Portable fundus camera image: 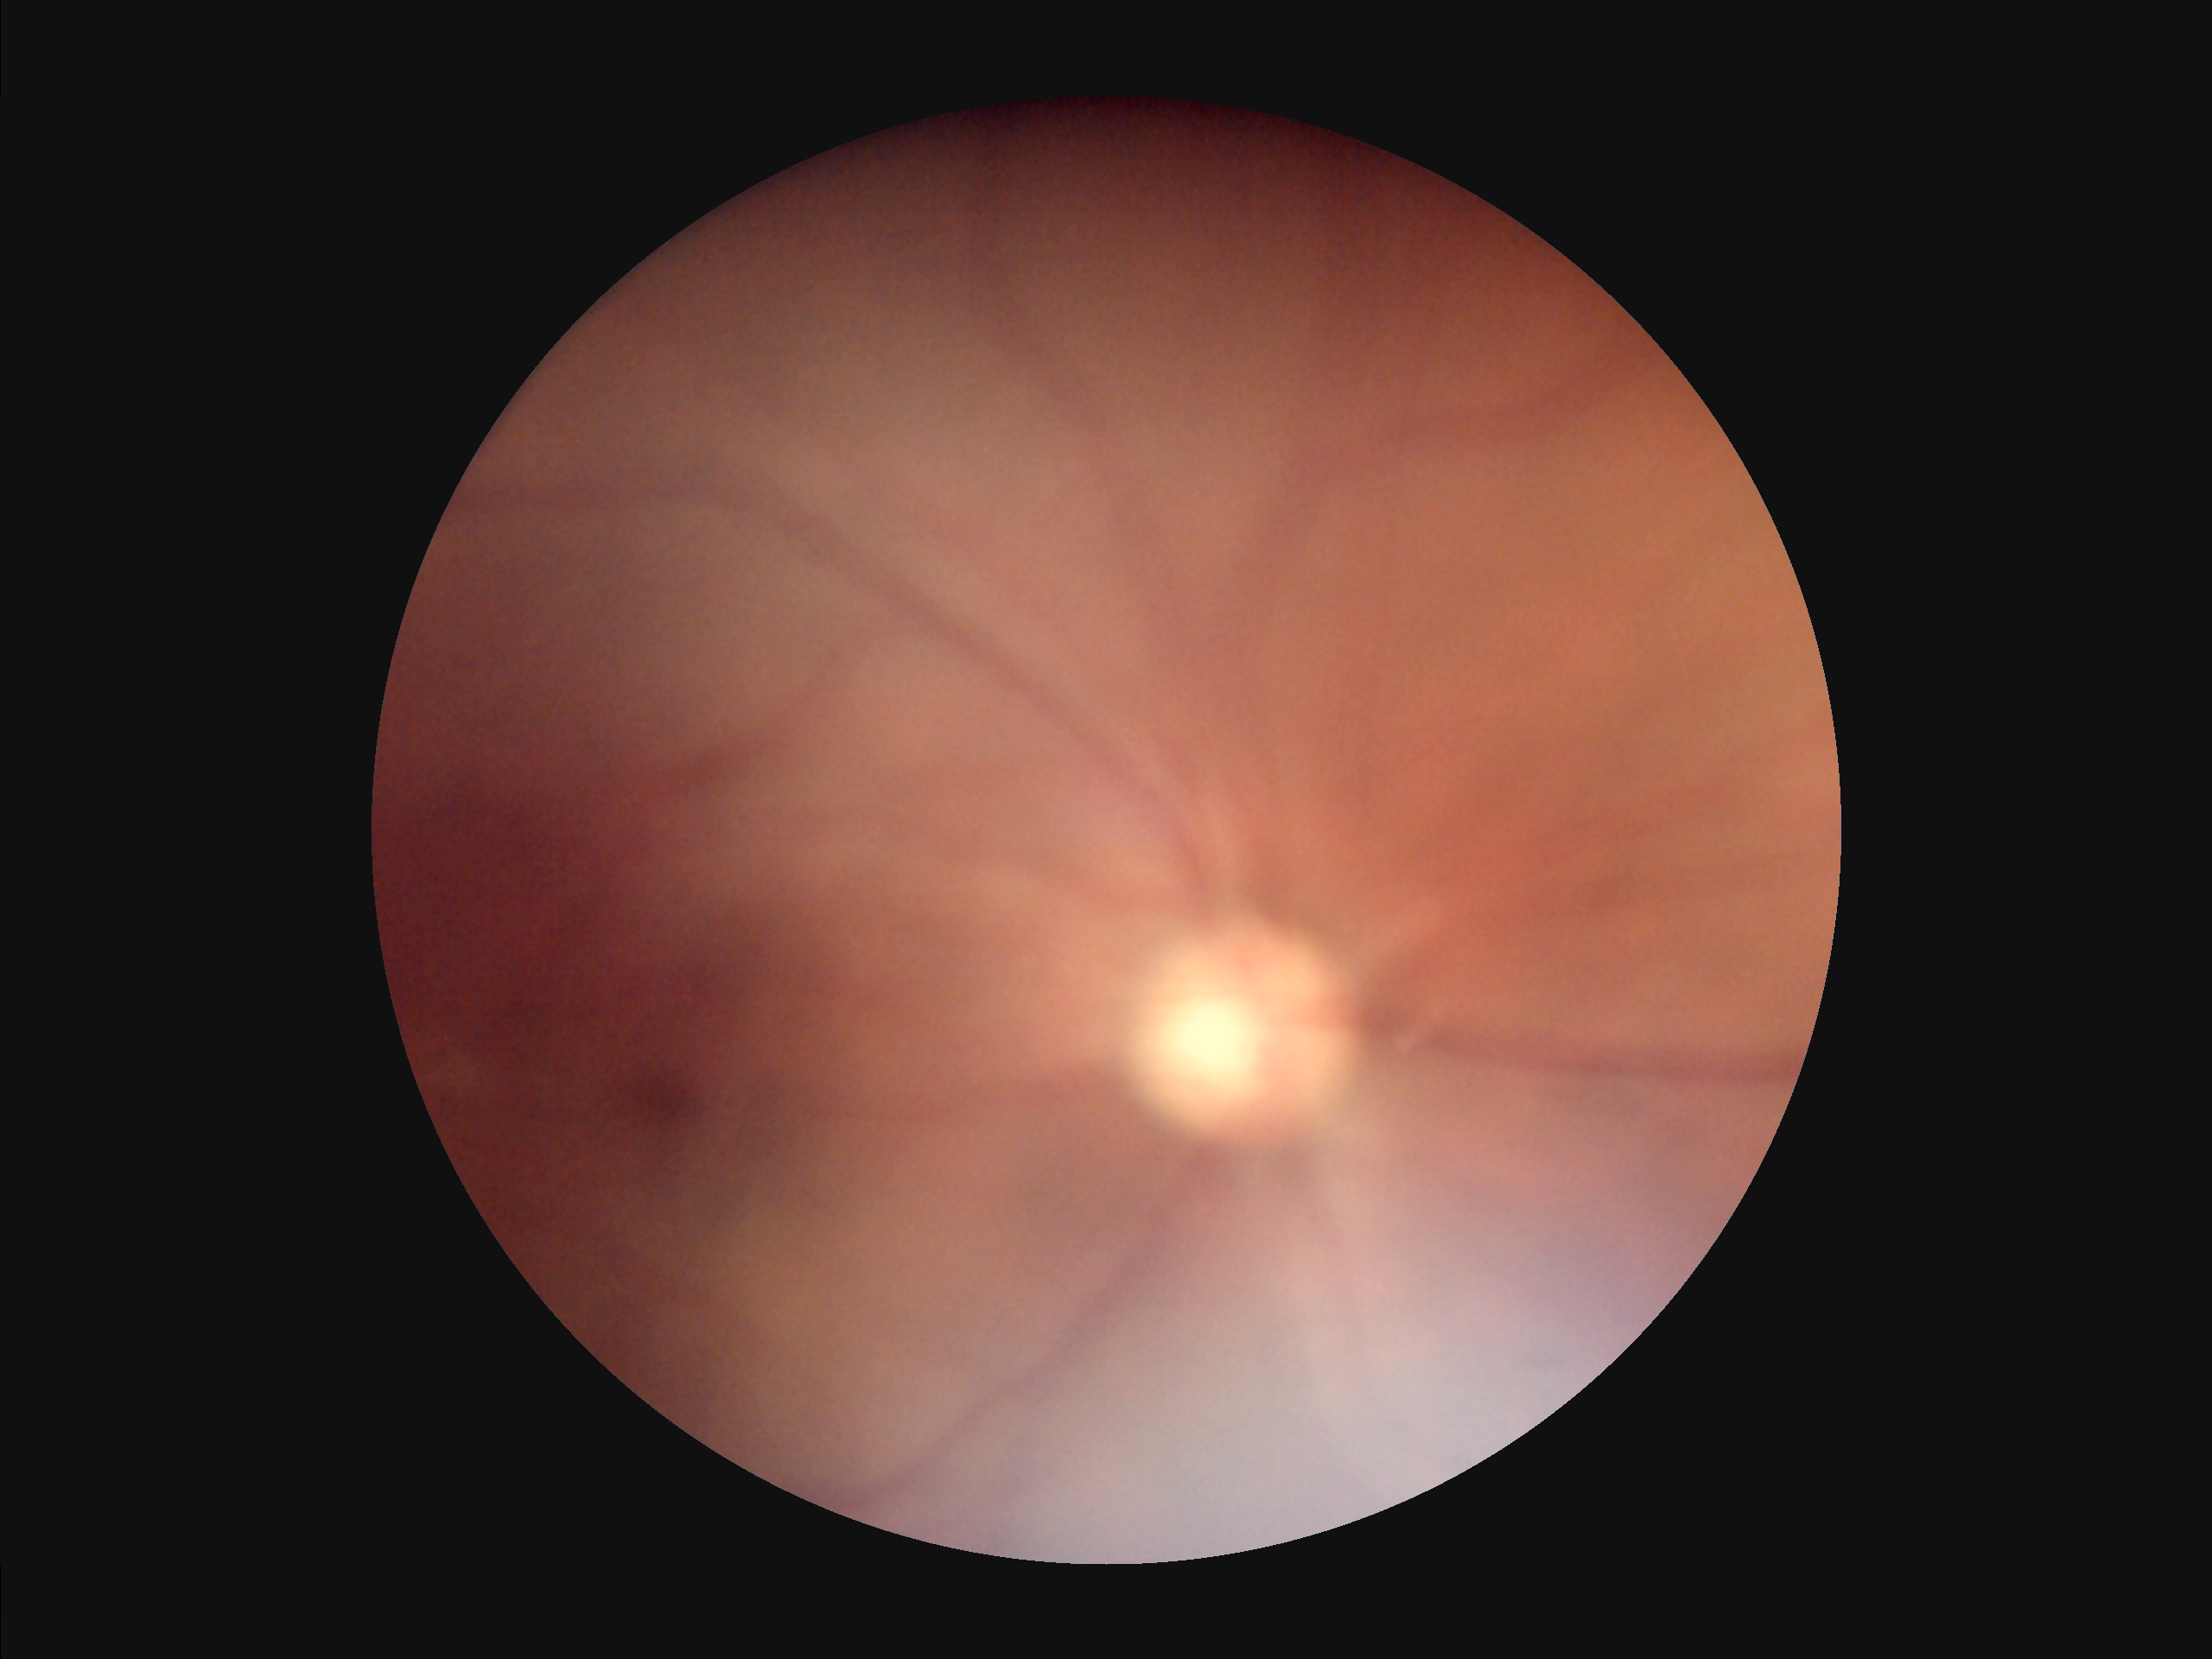 Contrast is low. No over- or under-exposure. Image quality is inadequate for diagnostic use. The image is blurry.